Color fundus image: 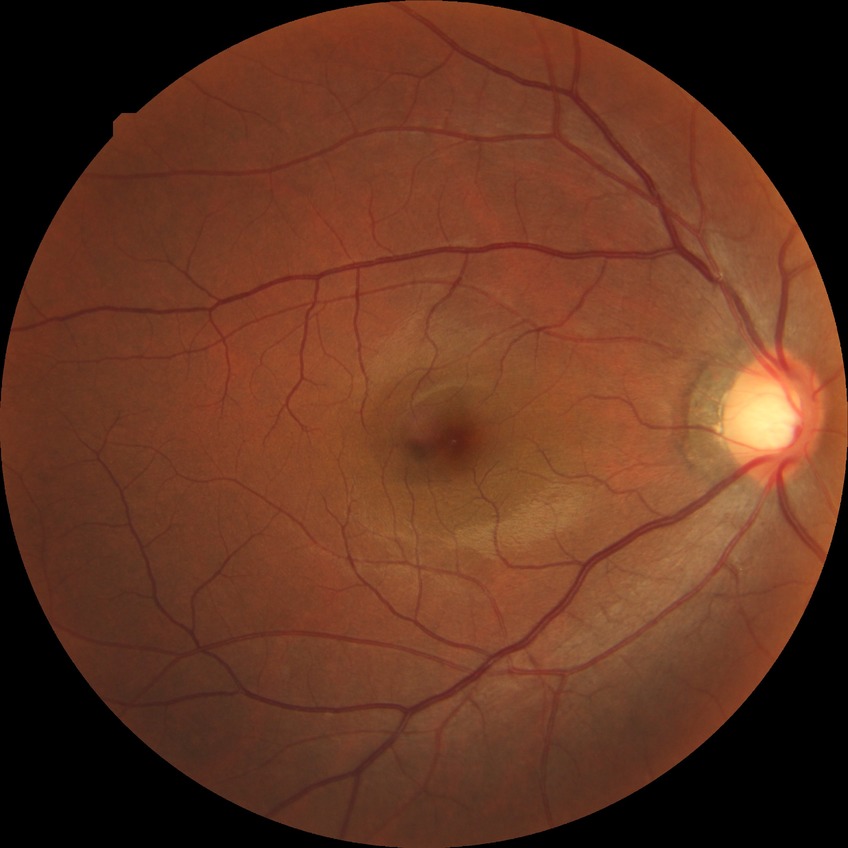

retinopathy grade = no diabetic retinopathy.